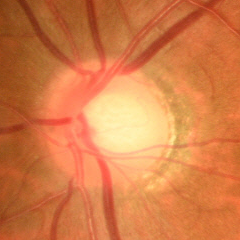 Findings consistent with glaucoma. Diagnosis: early-stage glaucoma.